848x848; NIDEK AFC-230 fundus camera; FOV: 45 degrees: 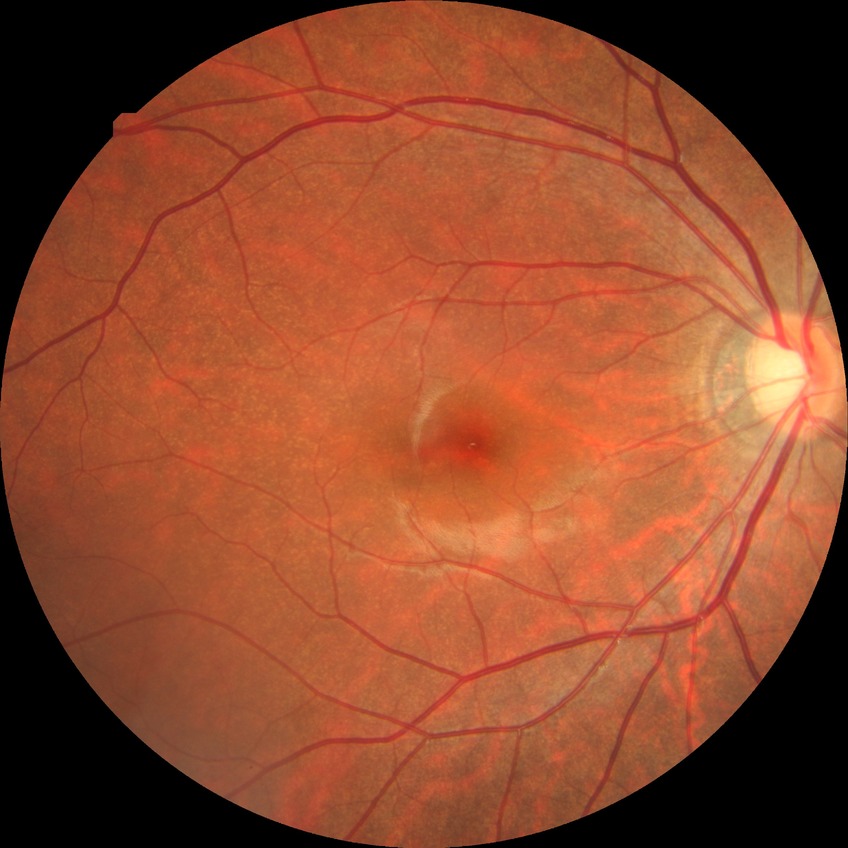

diabetic retinopathy (DR)=no diabetic retinopathy (NDR).